1240 by 1240 pixels · Phoenix ICON, 100° FOV · pediatric retinal photograph (wide-field)
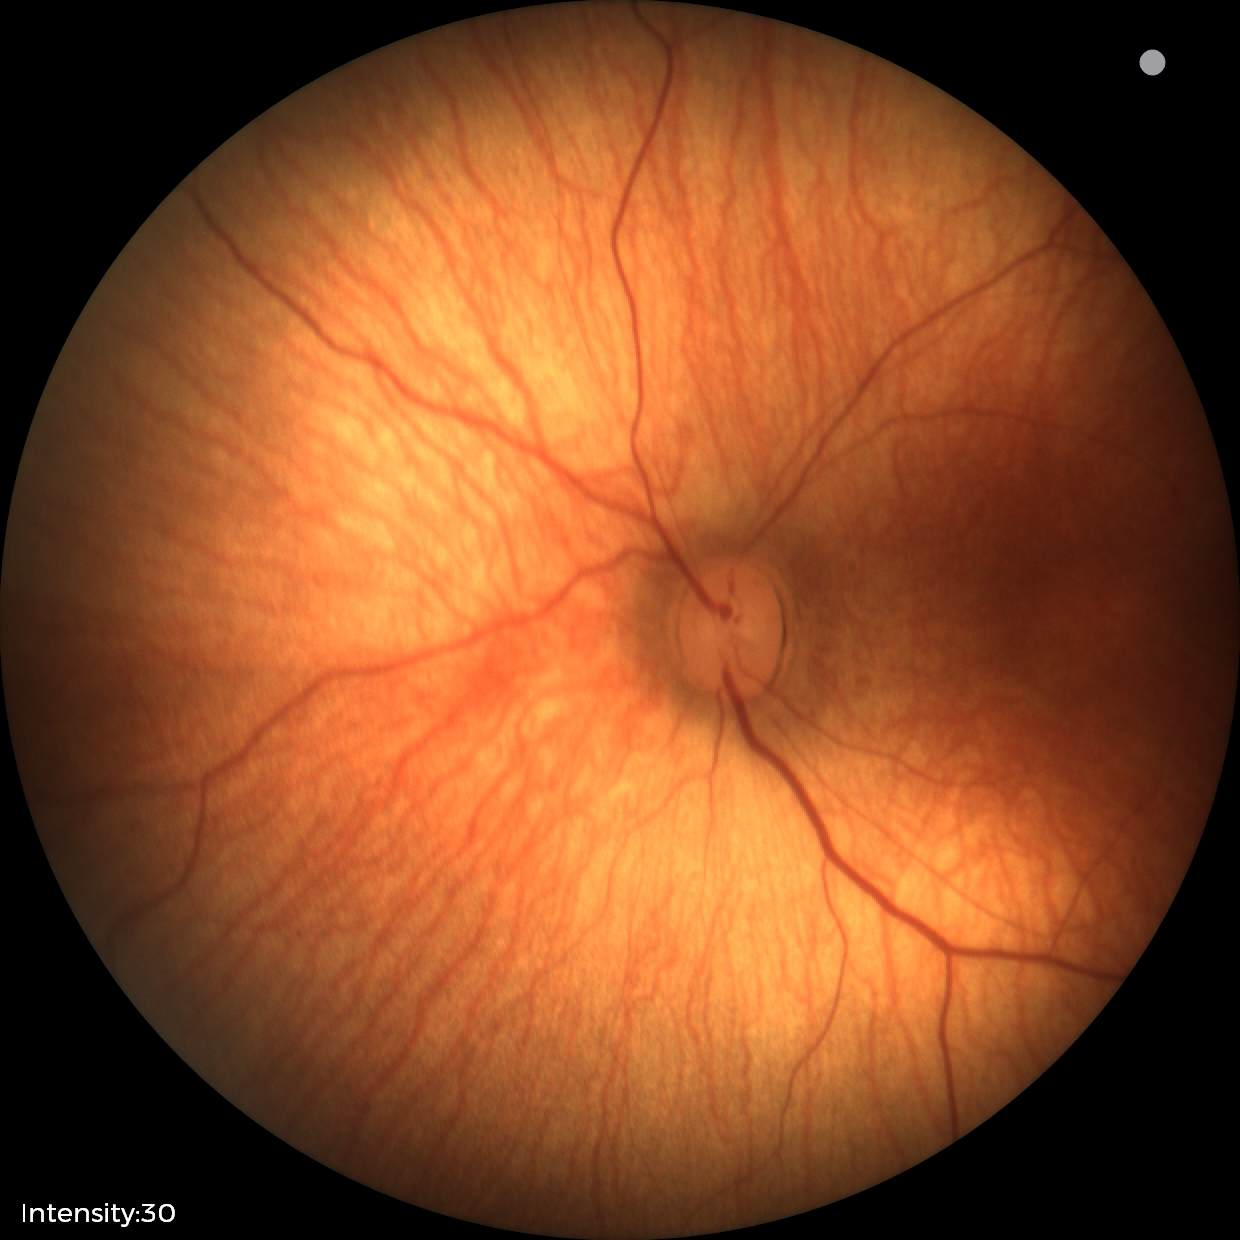 Impression = physiological